Davis DR grading
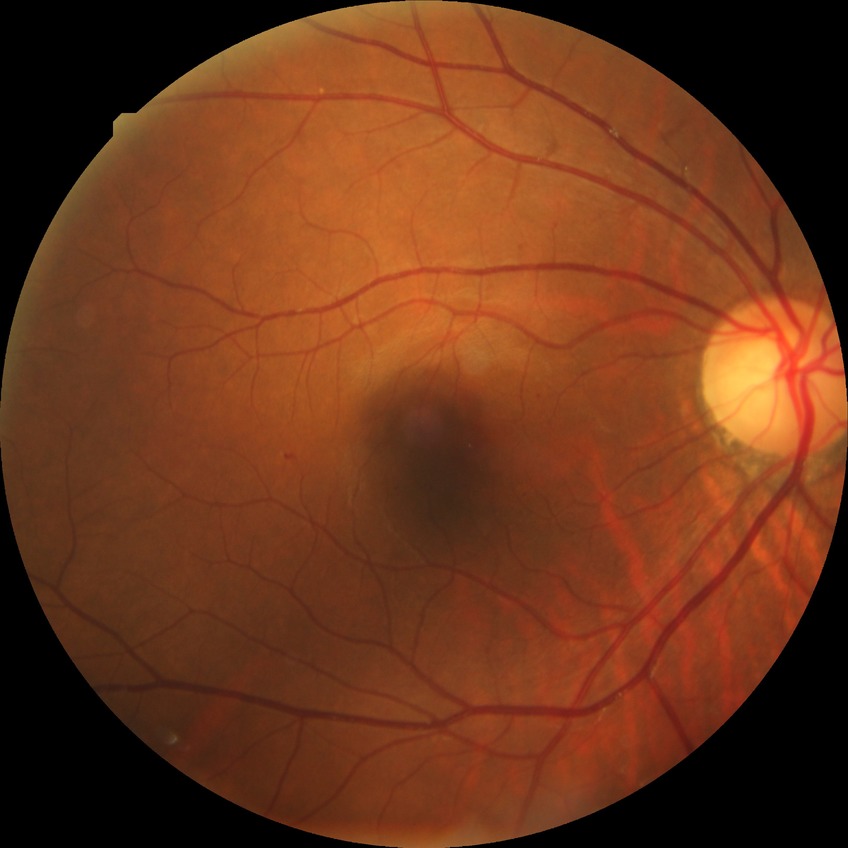 davis_grade: SDR (simple diabetic retinopathy)